45-degree field of view, 2352x1568, retinal fundus photograph.
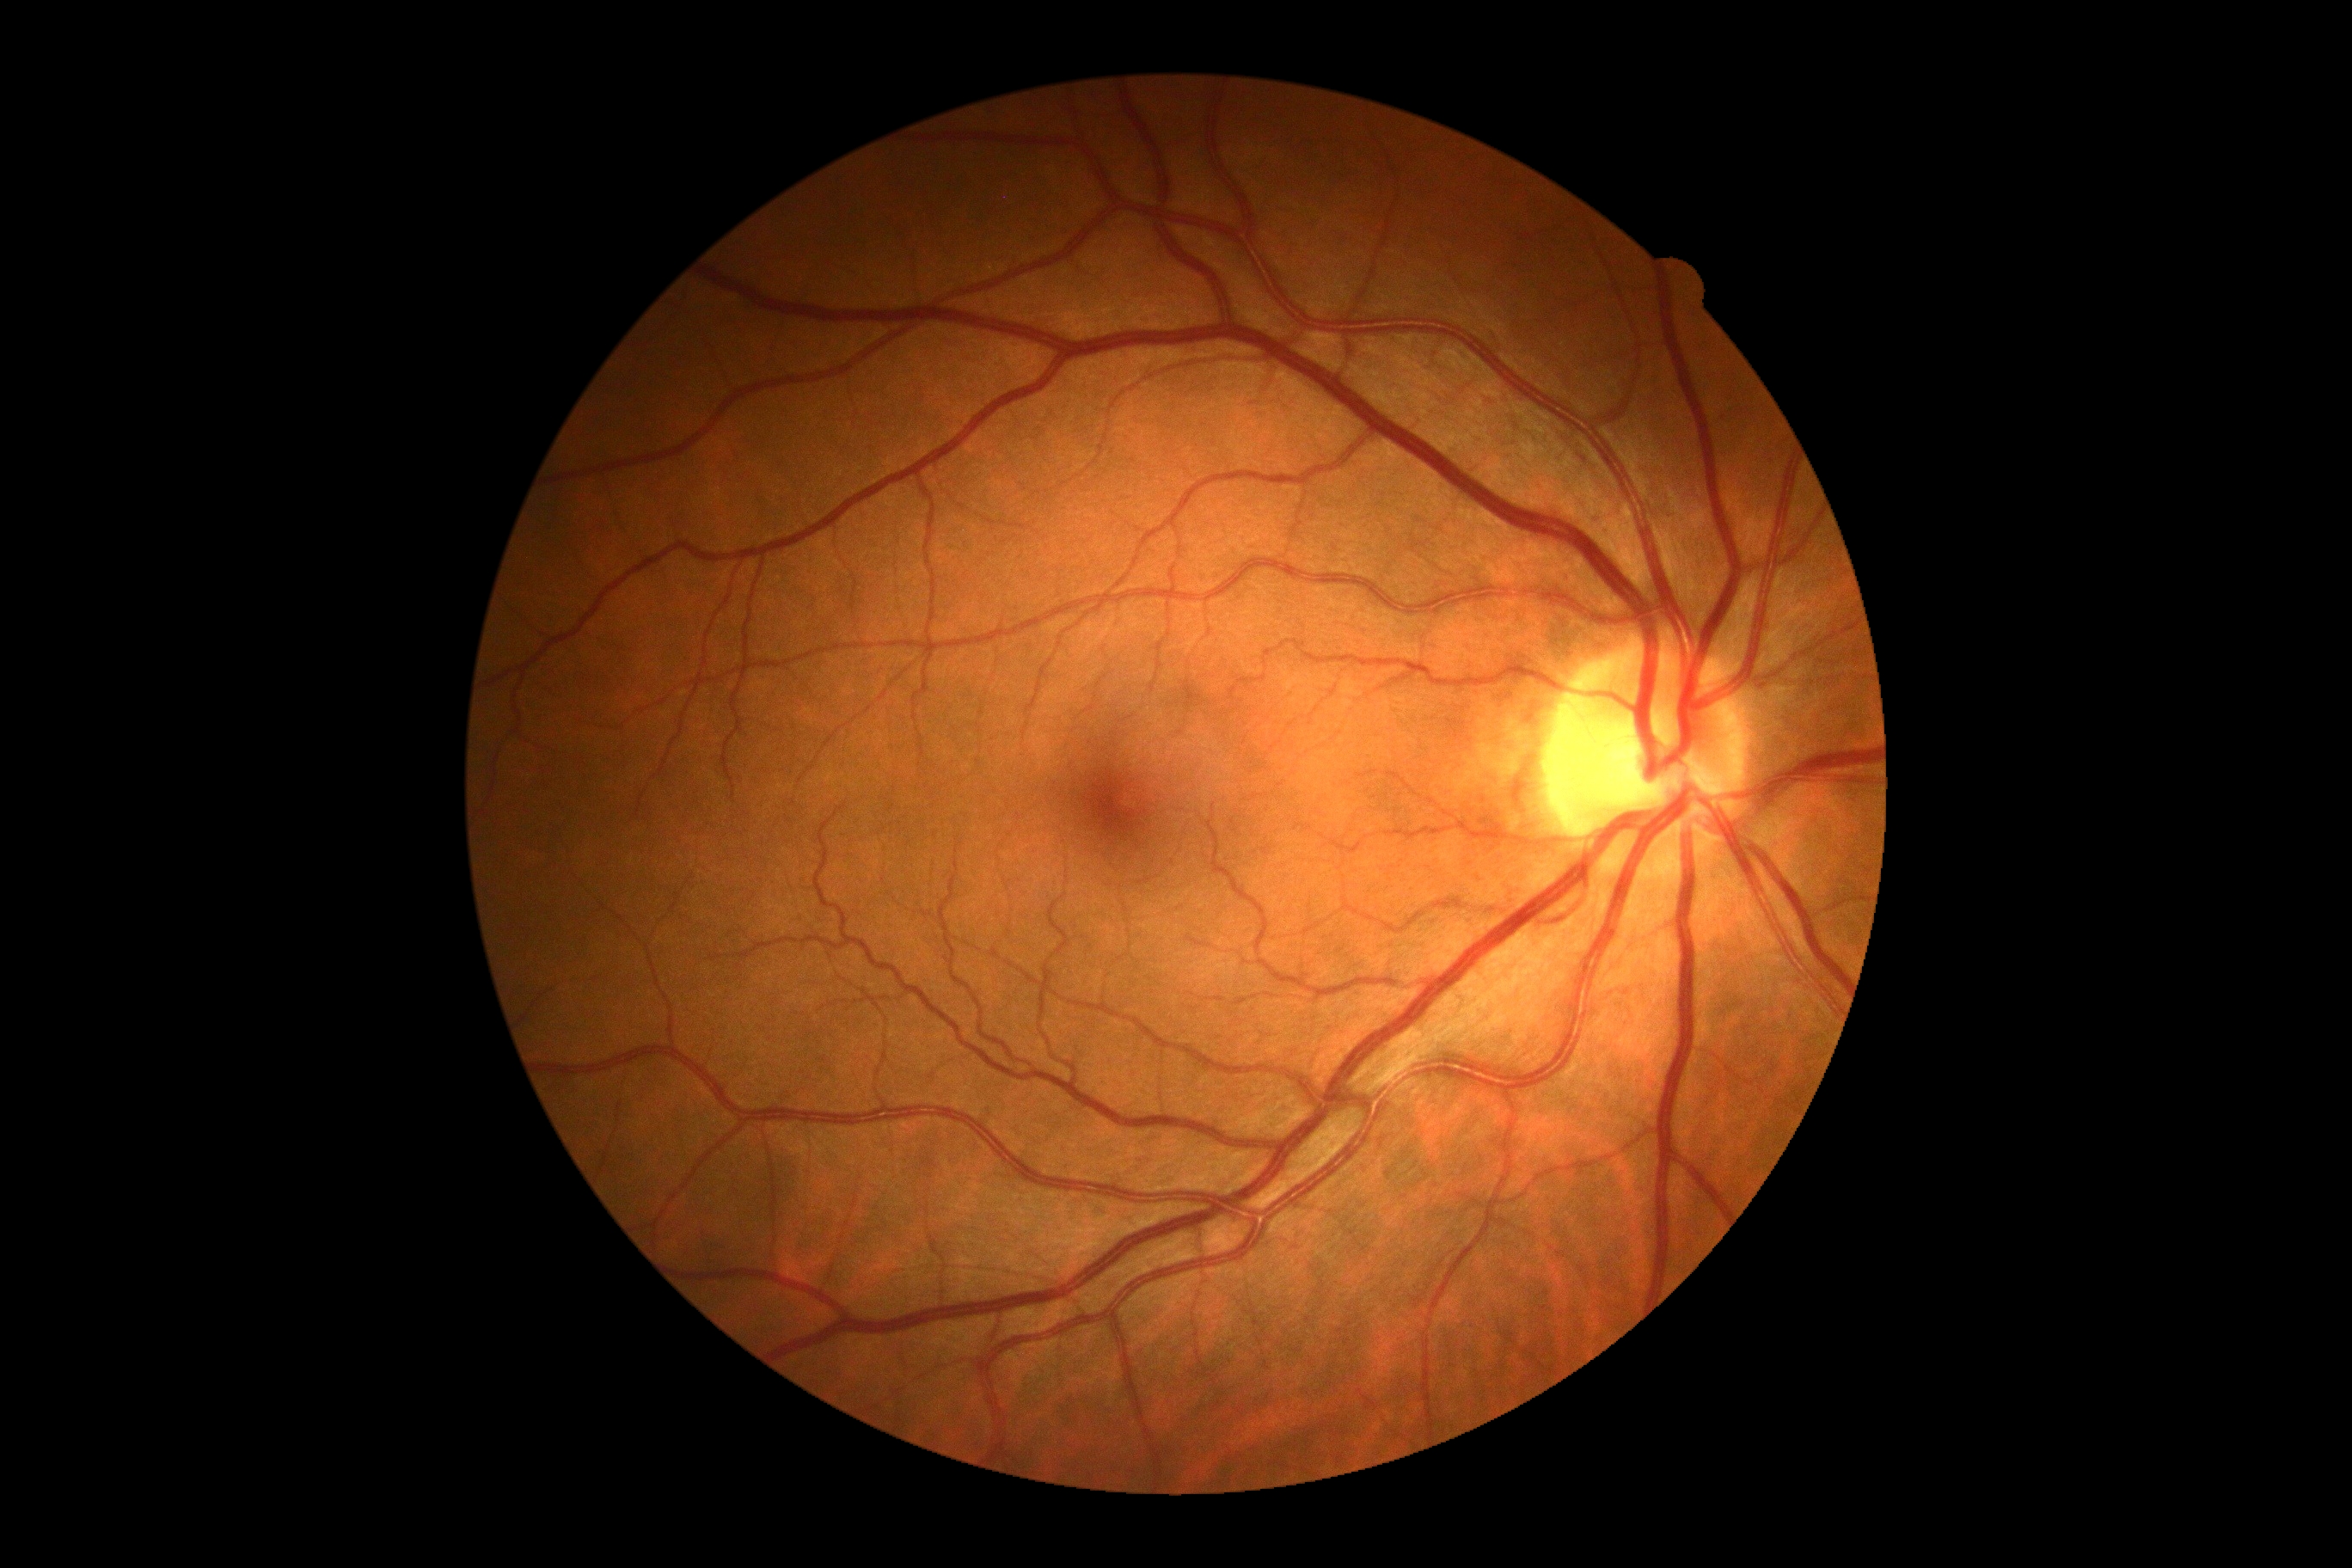

diabetic retinopathy (DR): grade 0, DR impression: no DR findings.